45° field of view
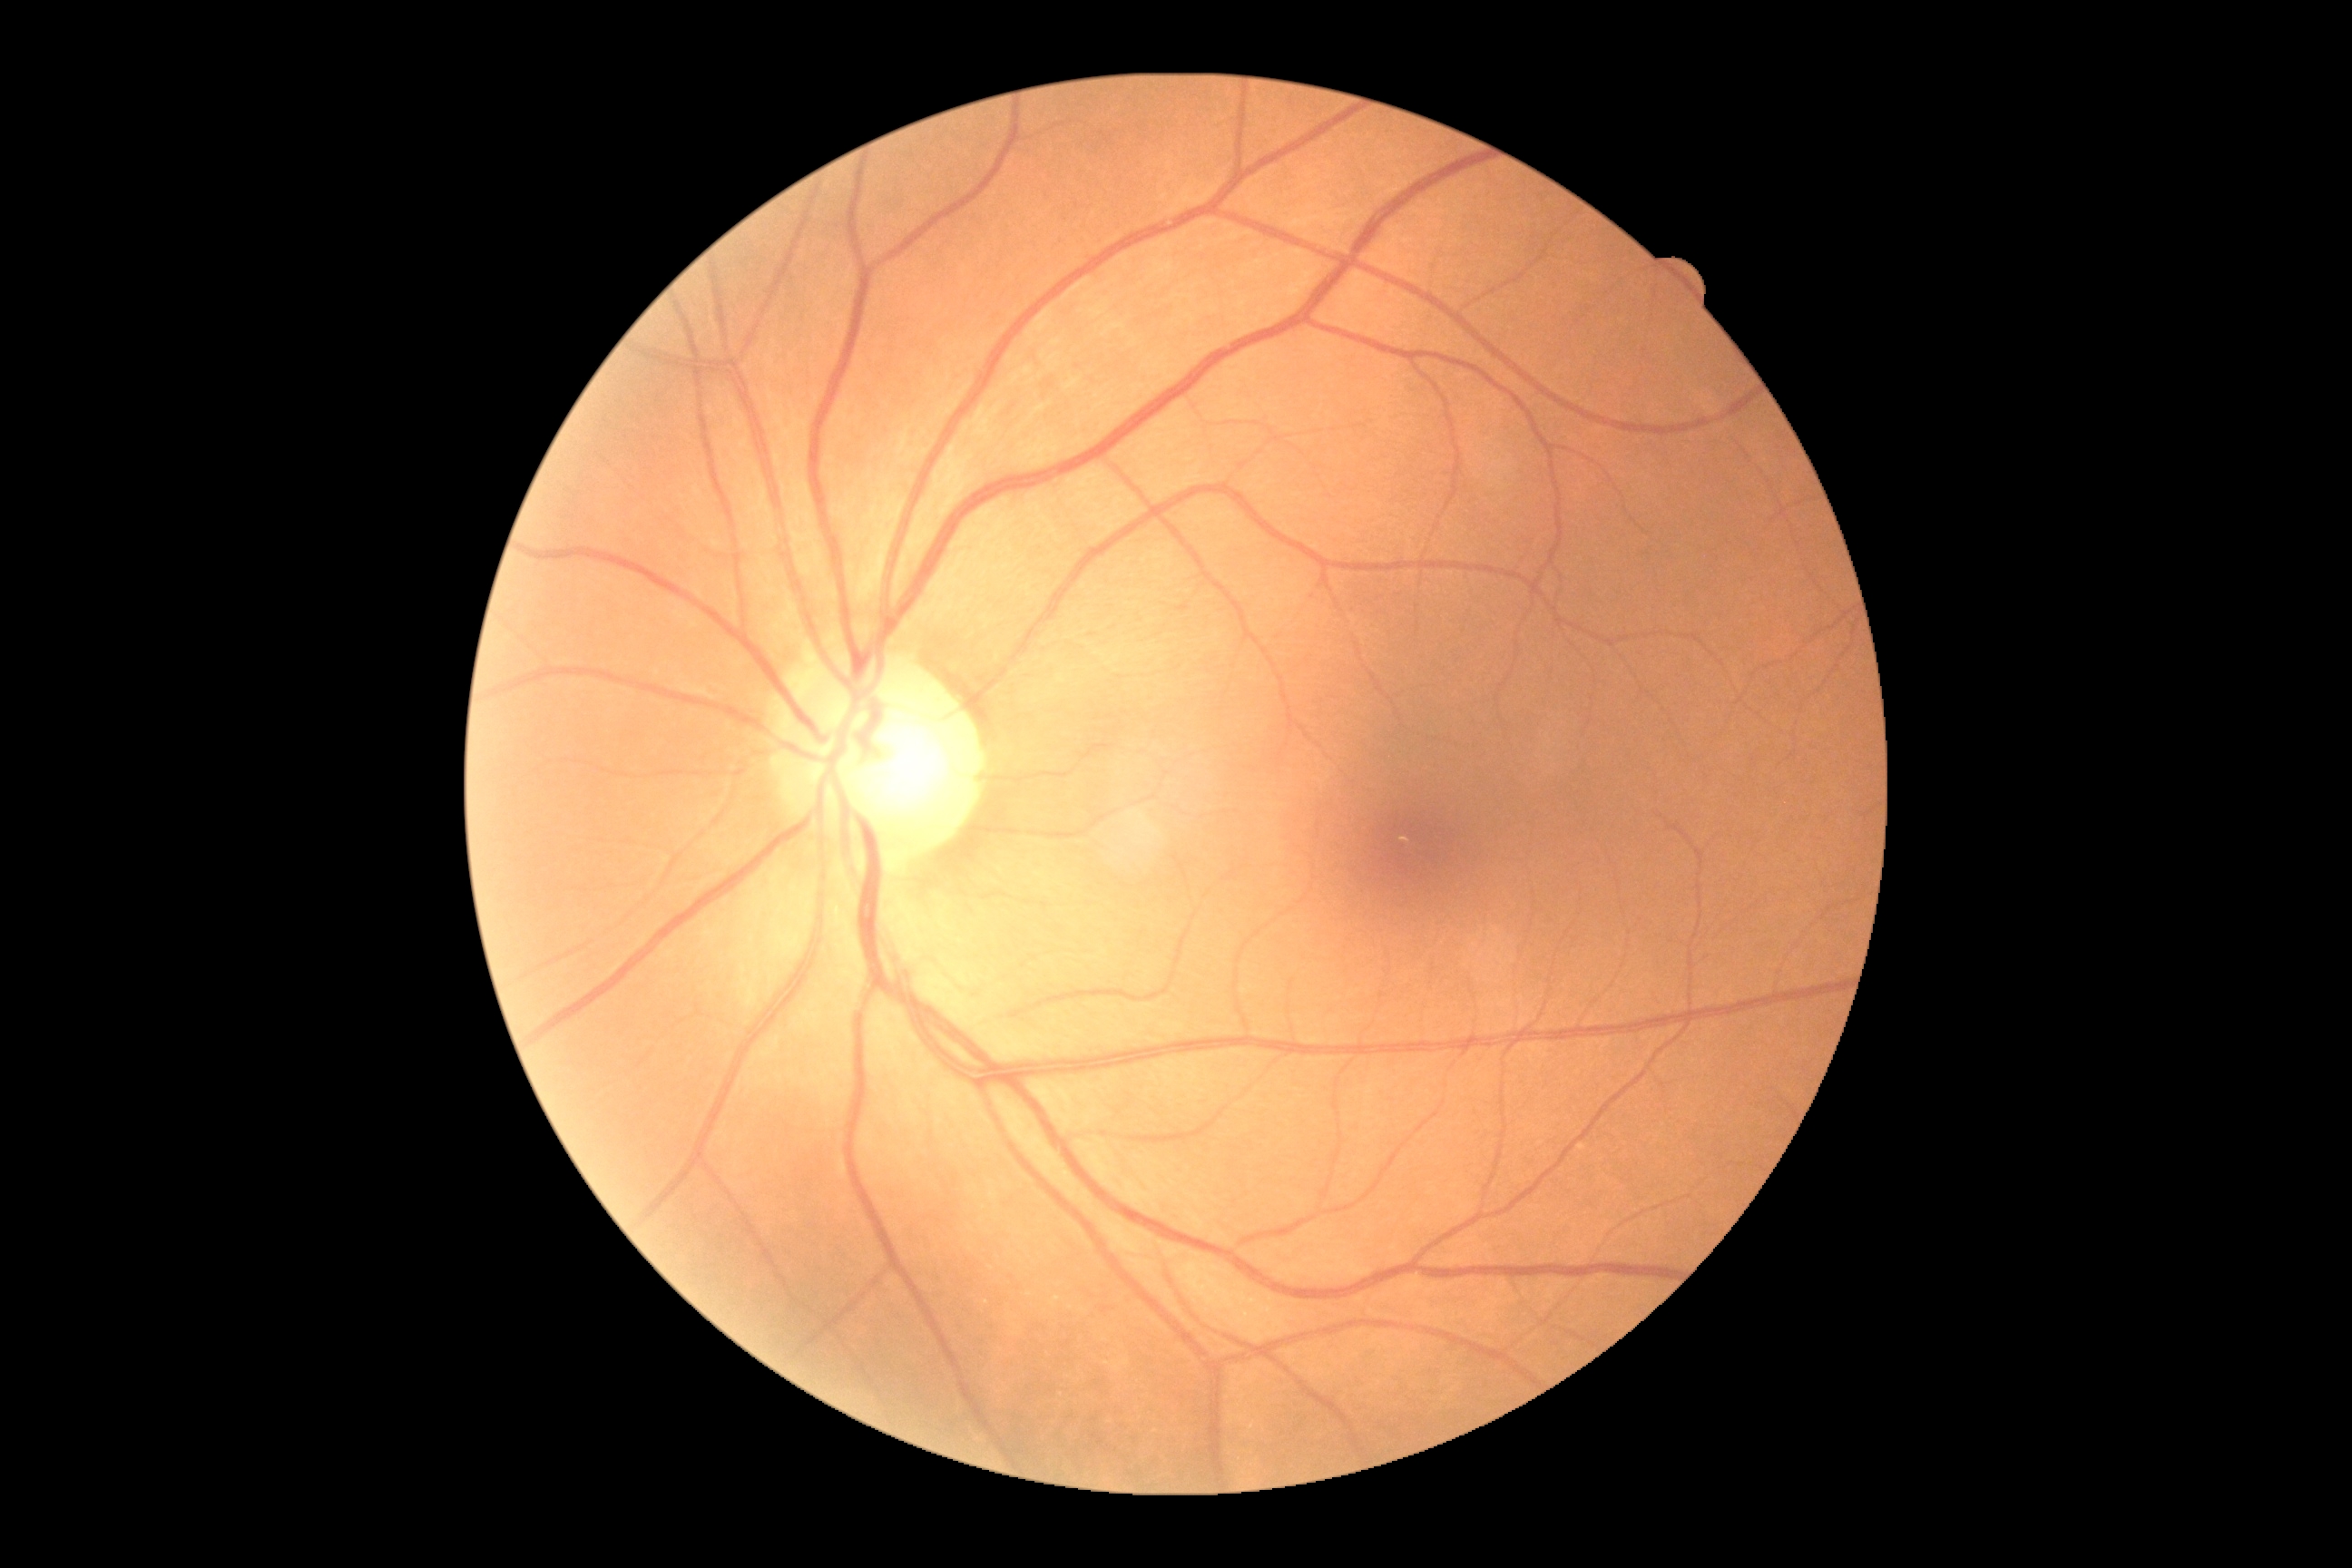
– DR impression: no DR findings
– diabetic retinopathy grade: no apparent retinopathy (0)